CFP:
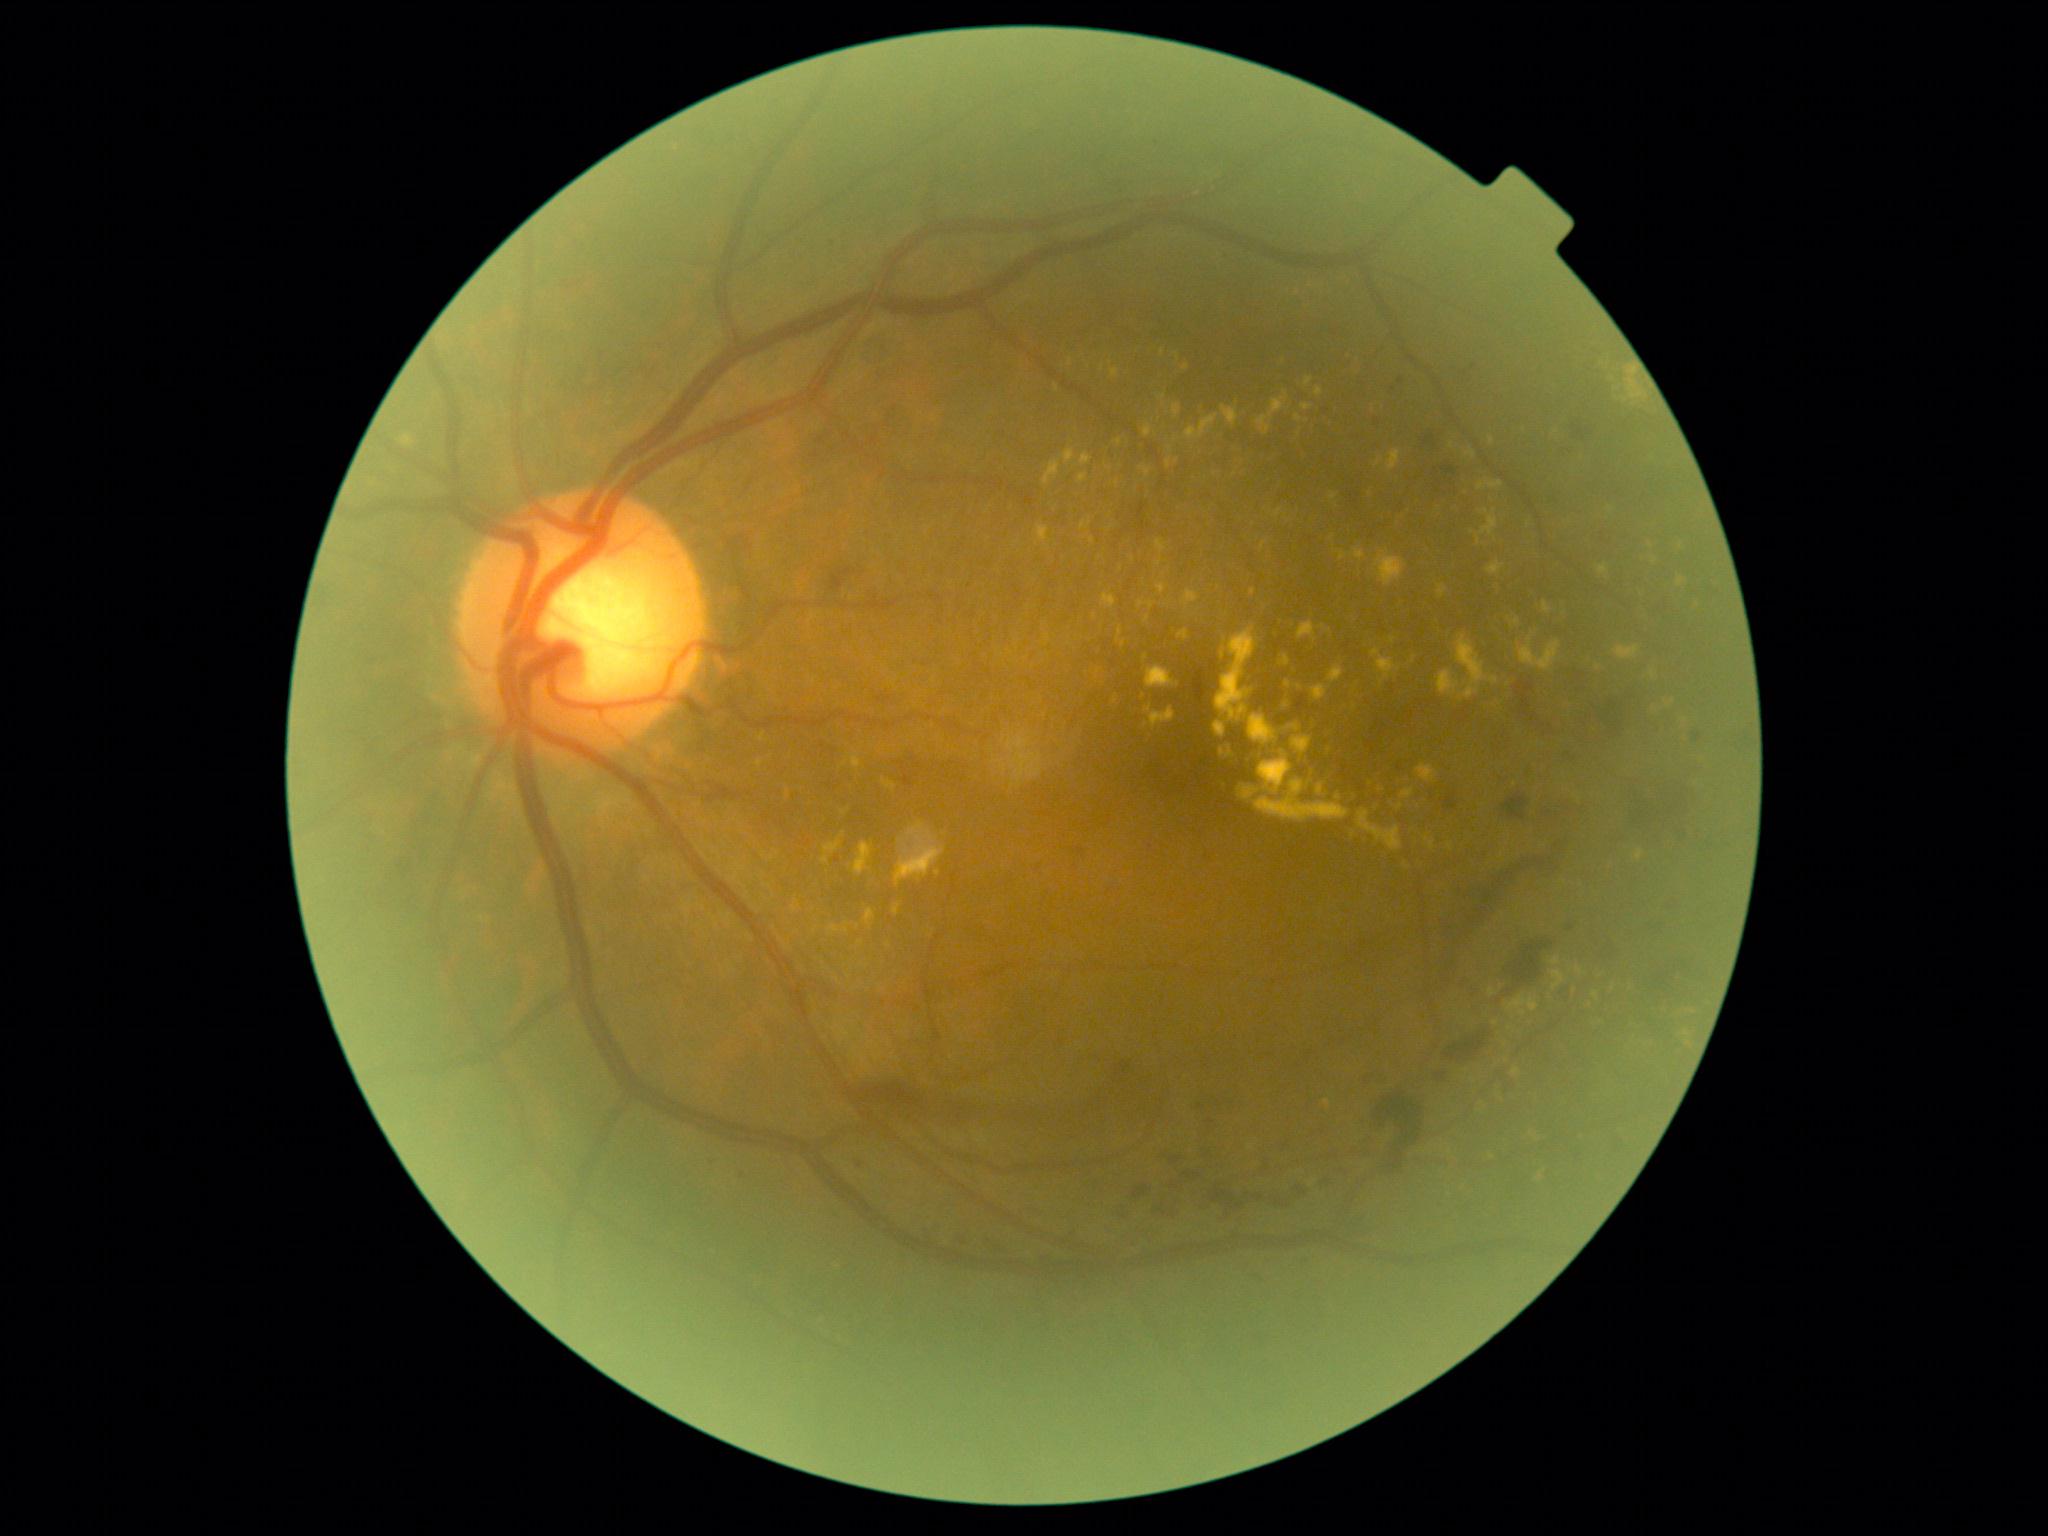 partial: true
dr_grade: 2
dr_grade_name: moderate NPDR
lesions:
  ex:
    - {"x1": 1416, "y1": 764, "x2": 1438, "y2": 782}
    - {"x1": 1078, "y1": 474, "x2": 1088, "y2": 484}
    - {"x1": 1144, "y1": 705, "x2": 1176, "y2": 730}
    - {"x1": 759, "y1": 734, "x2": 767, "y2": 743}
    - {"x1": 1478, "y1": 481, "x2": 1504, "y2": 491}
    - {"x1": 1375, "y1": 460, "x2": 1384, "y2": 467}
    - {"x1": 1426, "y1": 838, "x2": 1436, "y2": 851}
    - {"x1": 895, "y1": 822, "x2": 946, "y2": 887}
    - {"x1": 883, "y1": 780, "x2": 896, "y2": 792}
    - {"x1": 1305, "y1": 377, "x2": 1313, "y2": 388}
  ex_small:
    - (x=1099, y=671)
    - (x=1298, y=418)
    - (x=1251, y=1147)
    - (x=769, y=887)
    - (x=1111, y=362)
    - (x=795, y=909)
    - (x=1229, y=755)
    - (x=1598, y=667)
    - (x=1147, y=619)